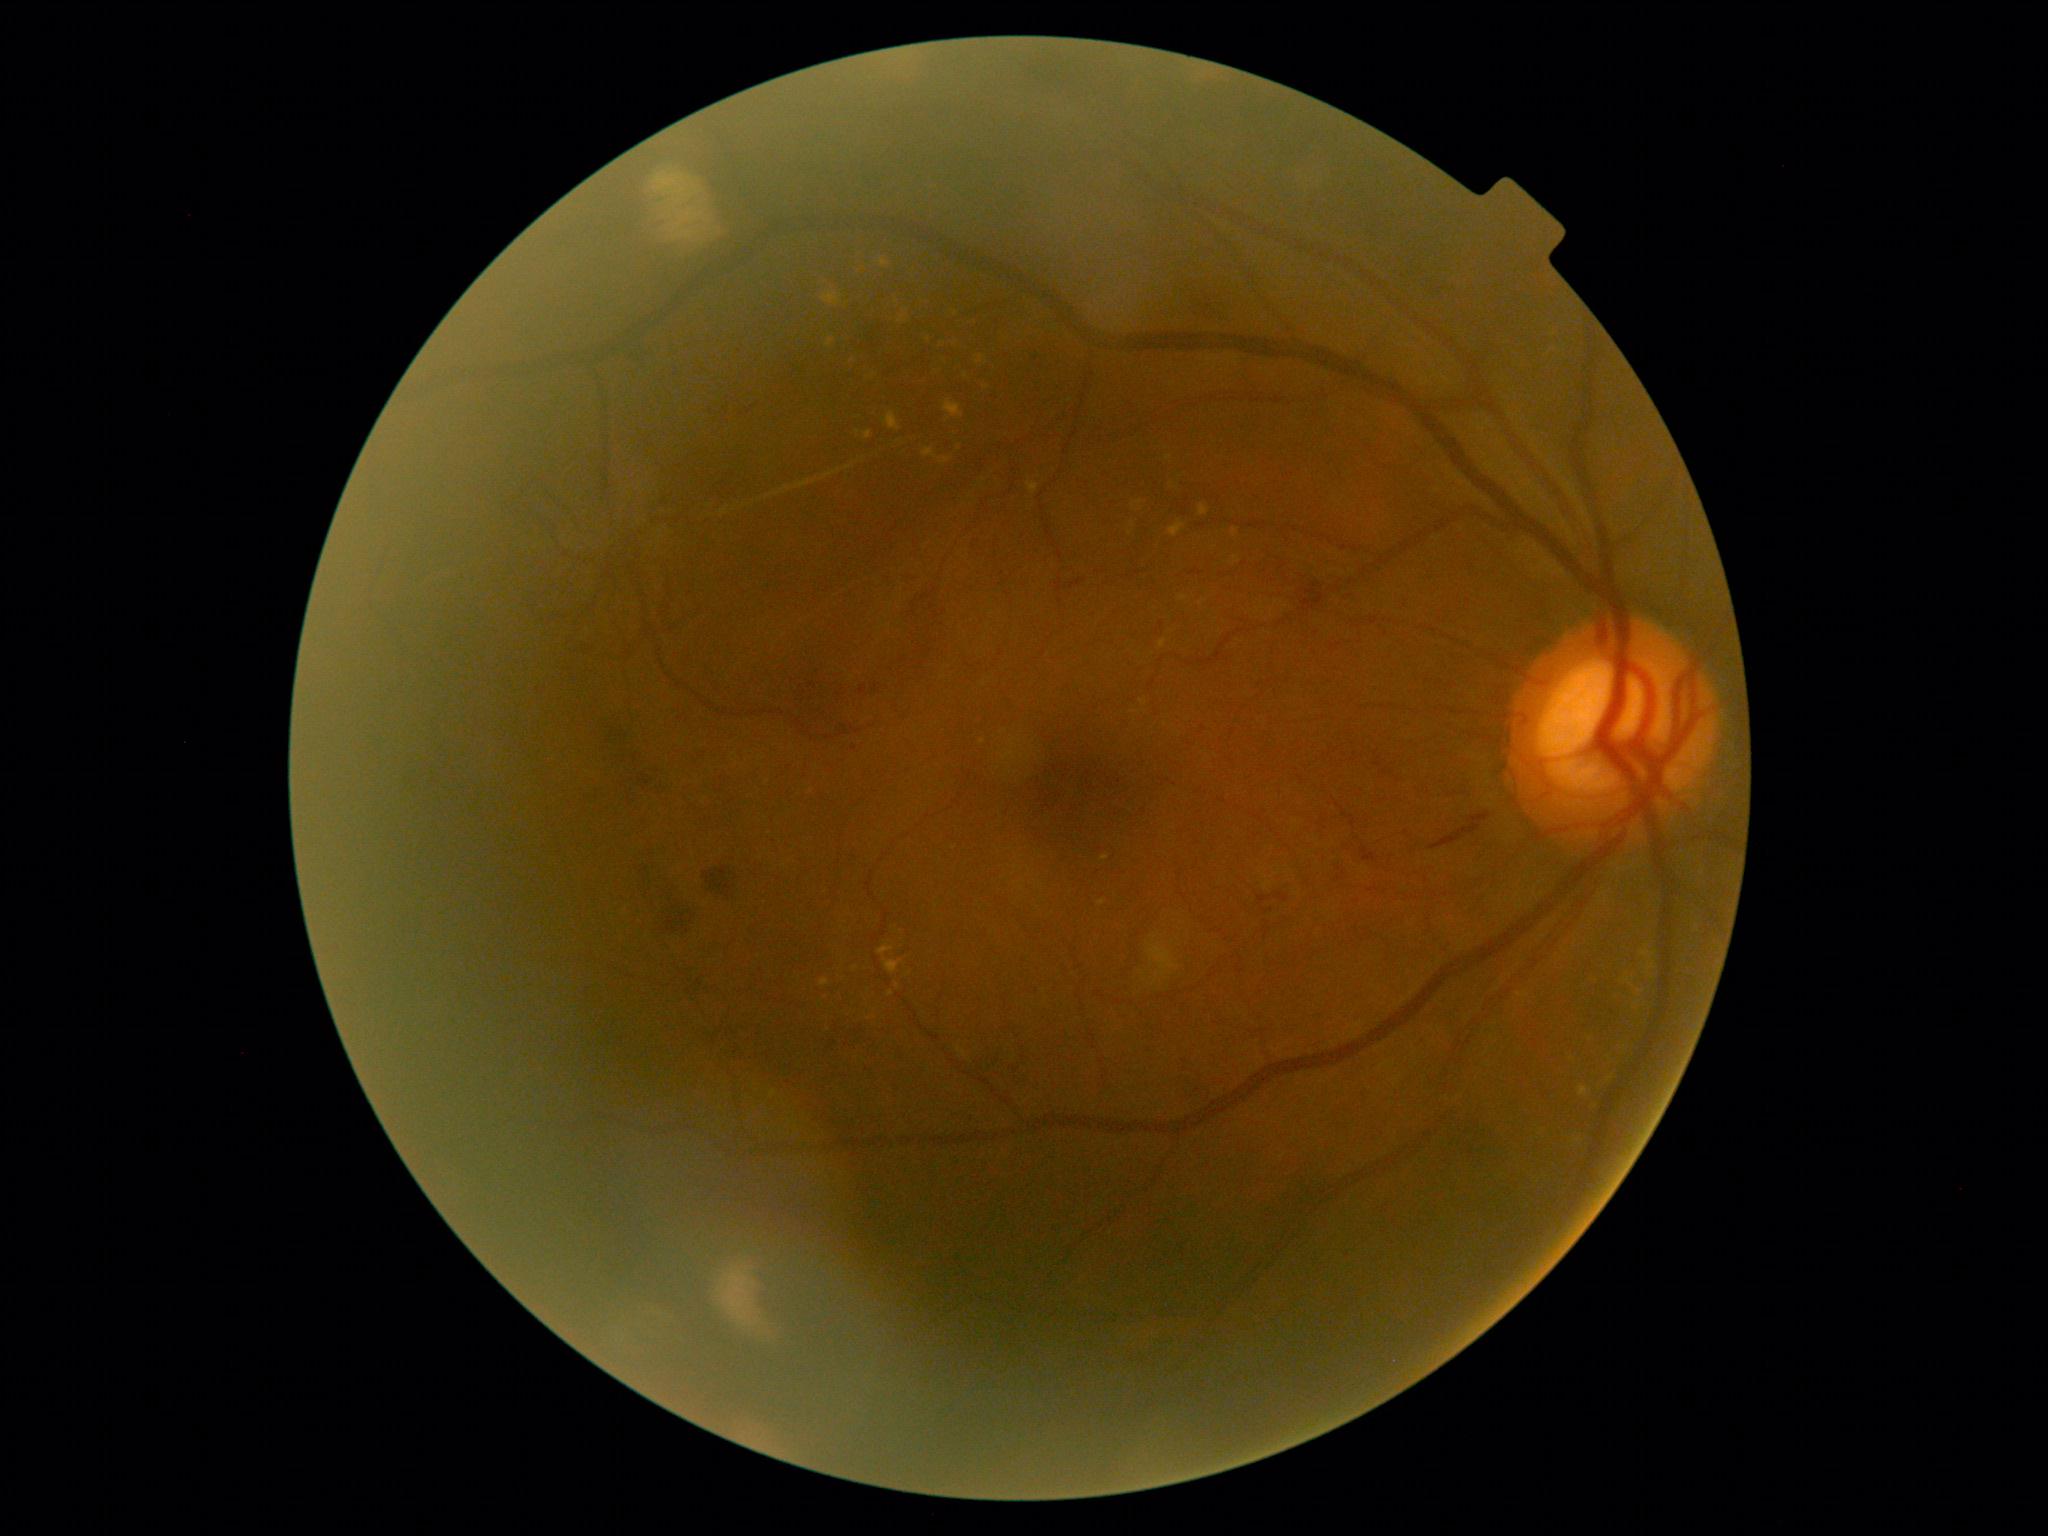

– DR grade: 3 (severe NPDR)